DR severity per modified Davis staging: 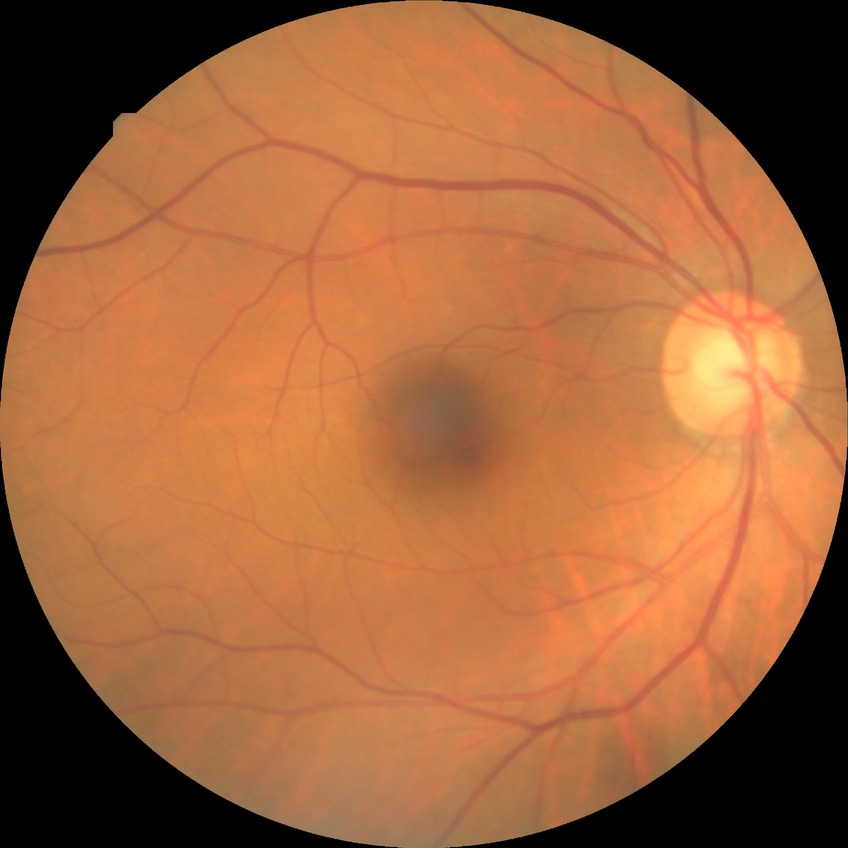

  davis_grade: no diabetic retinopathy (NDR)